Wide-field fundus photograph of an infant. 640x480:
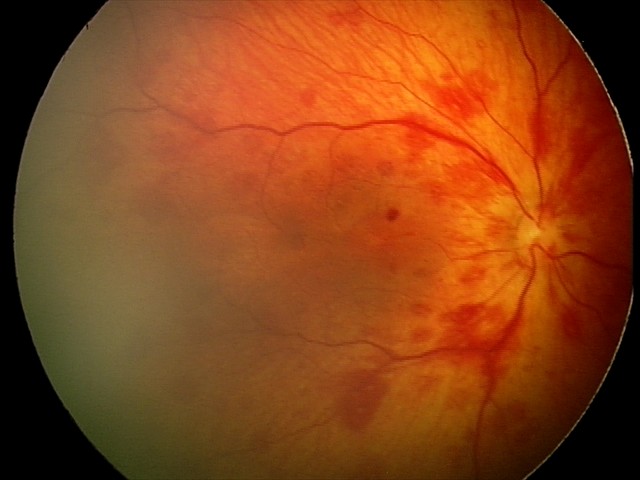

Diagnosis: retinal hemorrhages.